50° FOV, dilated-pupil acquisition.
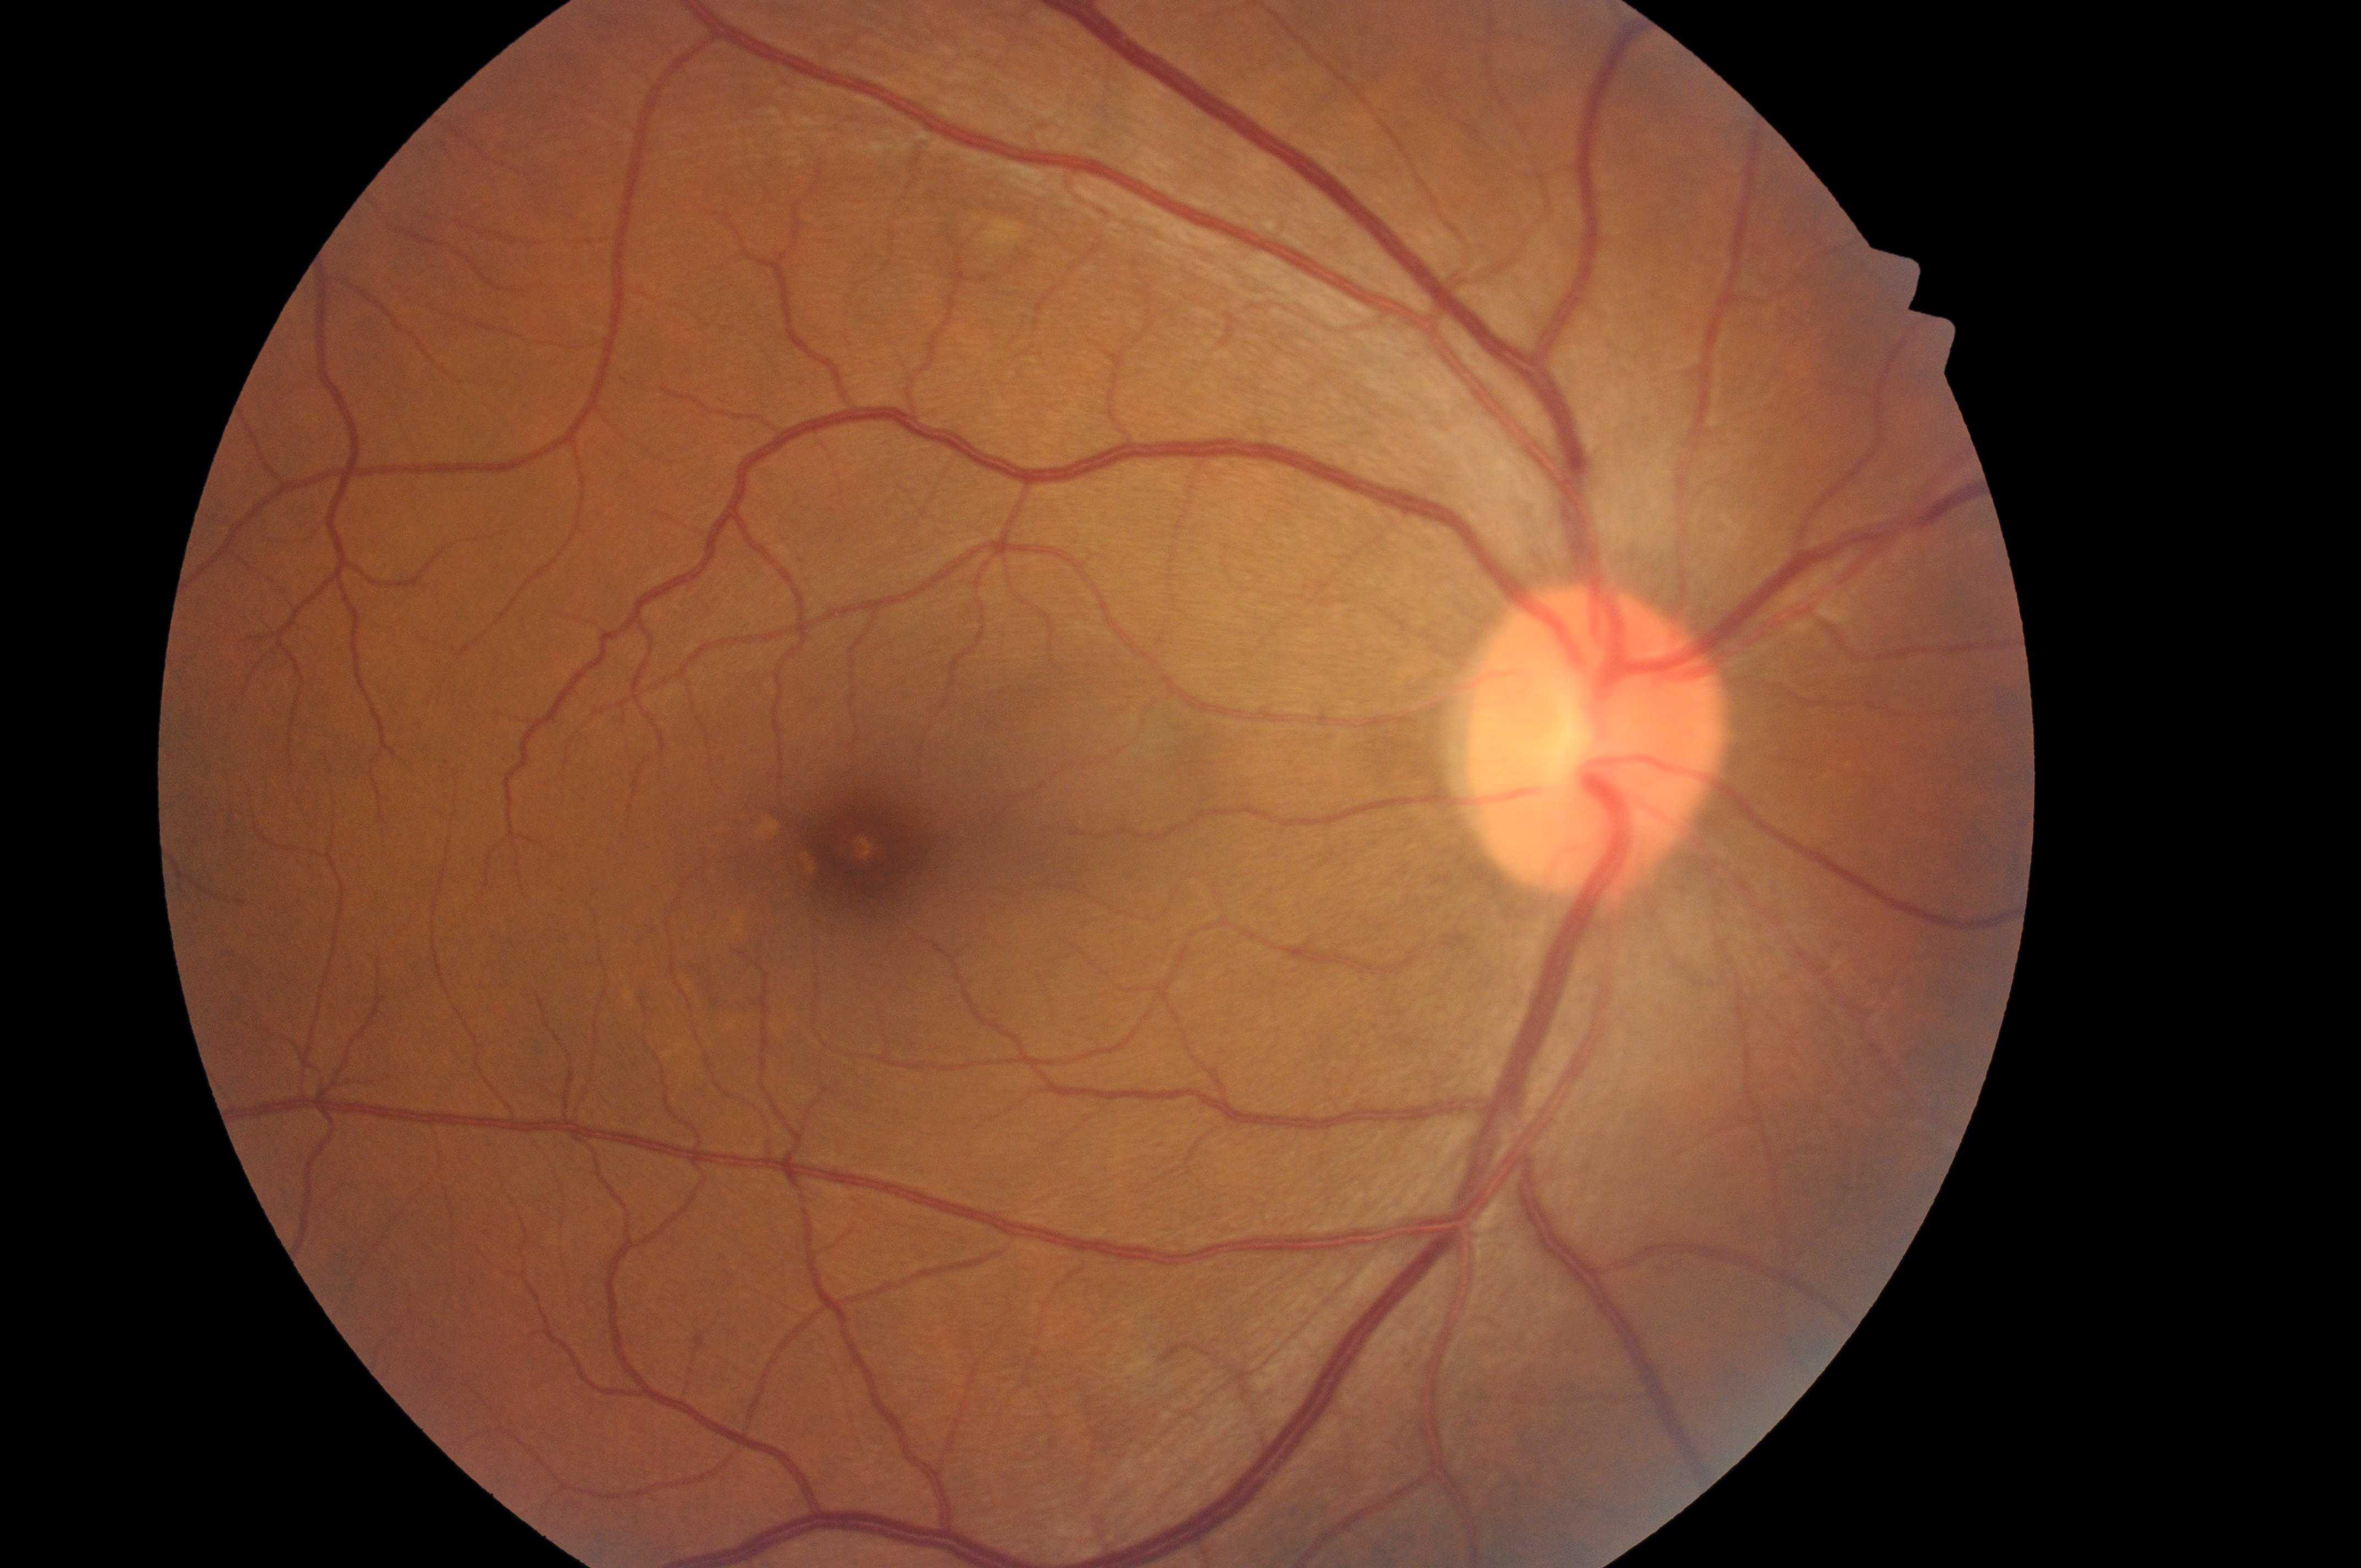 DR severity: grade 0 (no apparent retinopathy). The image shows the OD. Fovea: [871, 859]. The optic disc is at [1584, 742]. DME risk is no risk (grade 0).